Retinal fundus photograph; 2144 by 1424 pixels; FOV: 45 degrees: 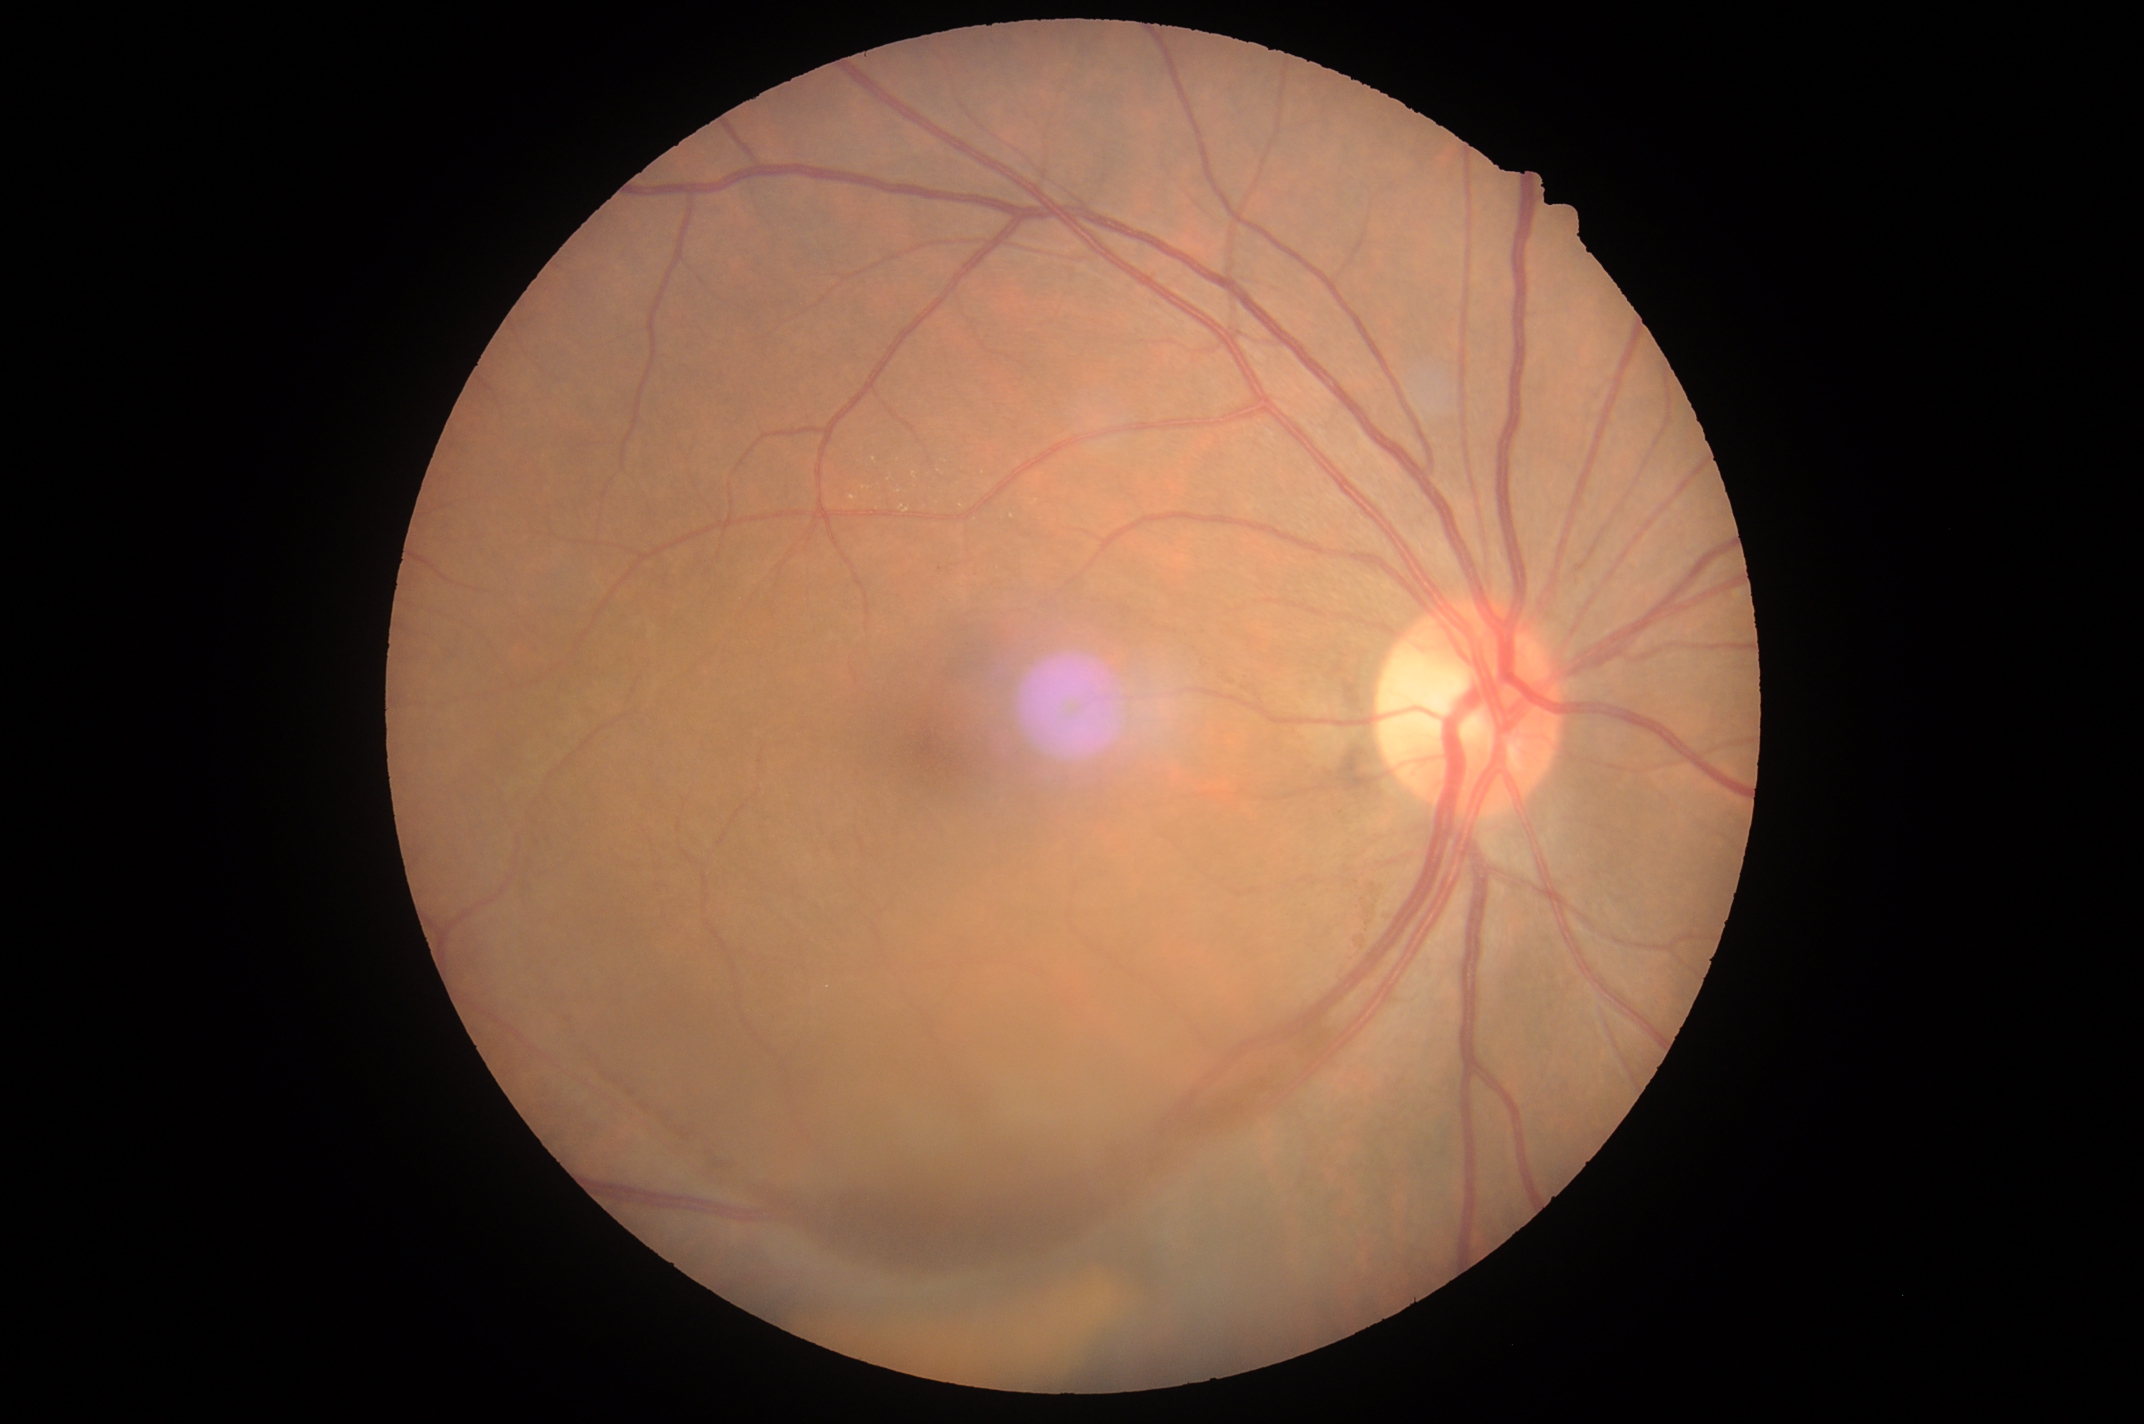

Annotations:
- DR class: proliferative diabetic retinopathy
- DR stage: grade 4